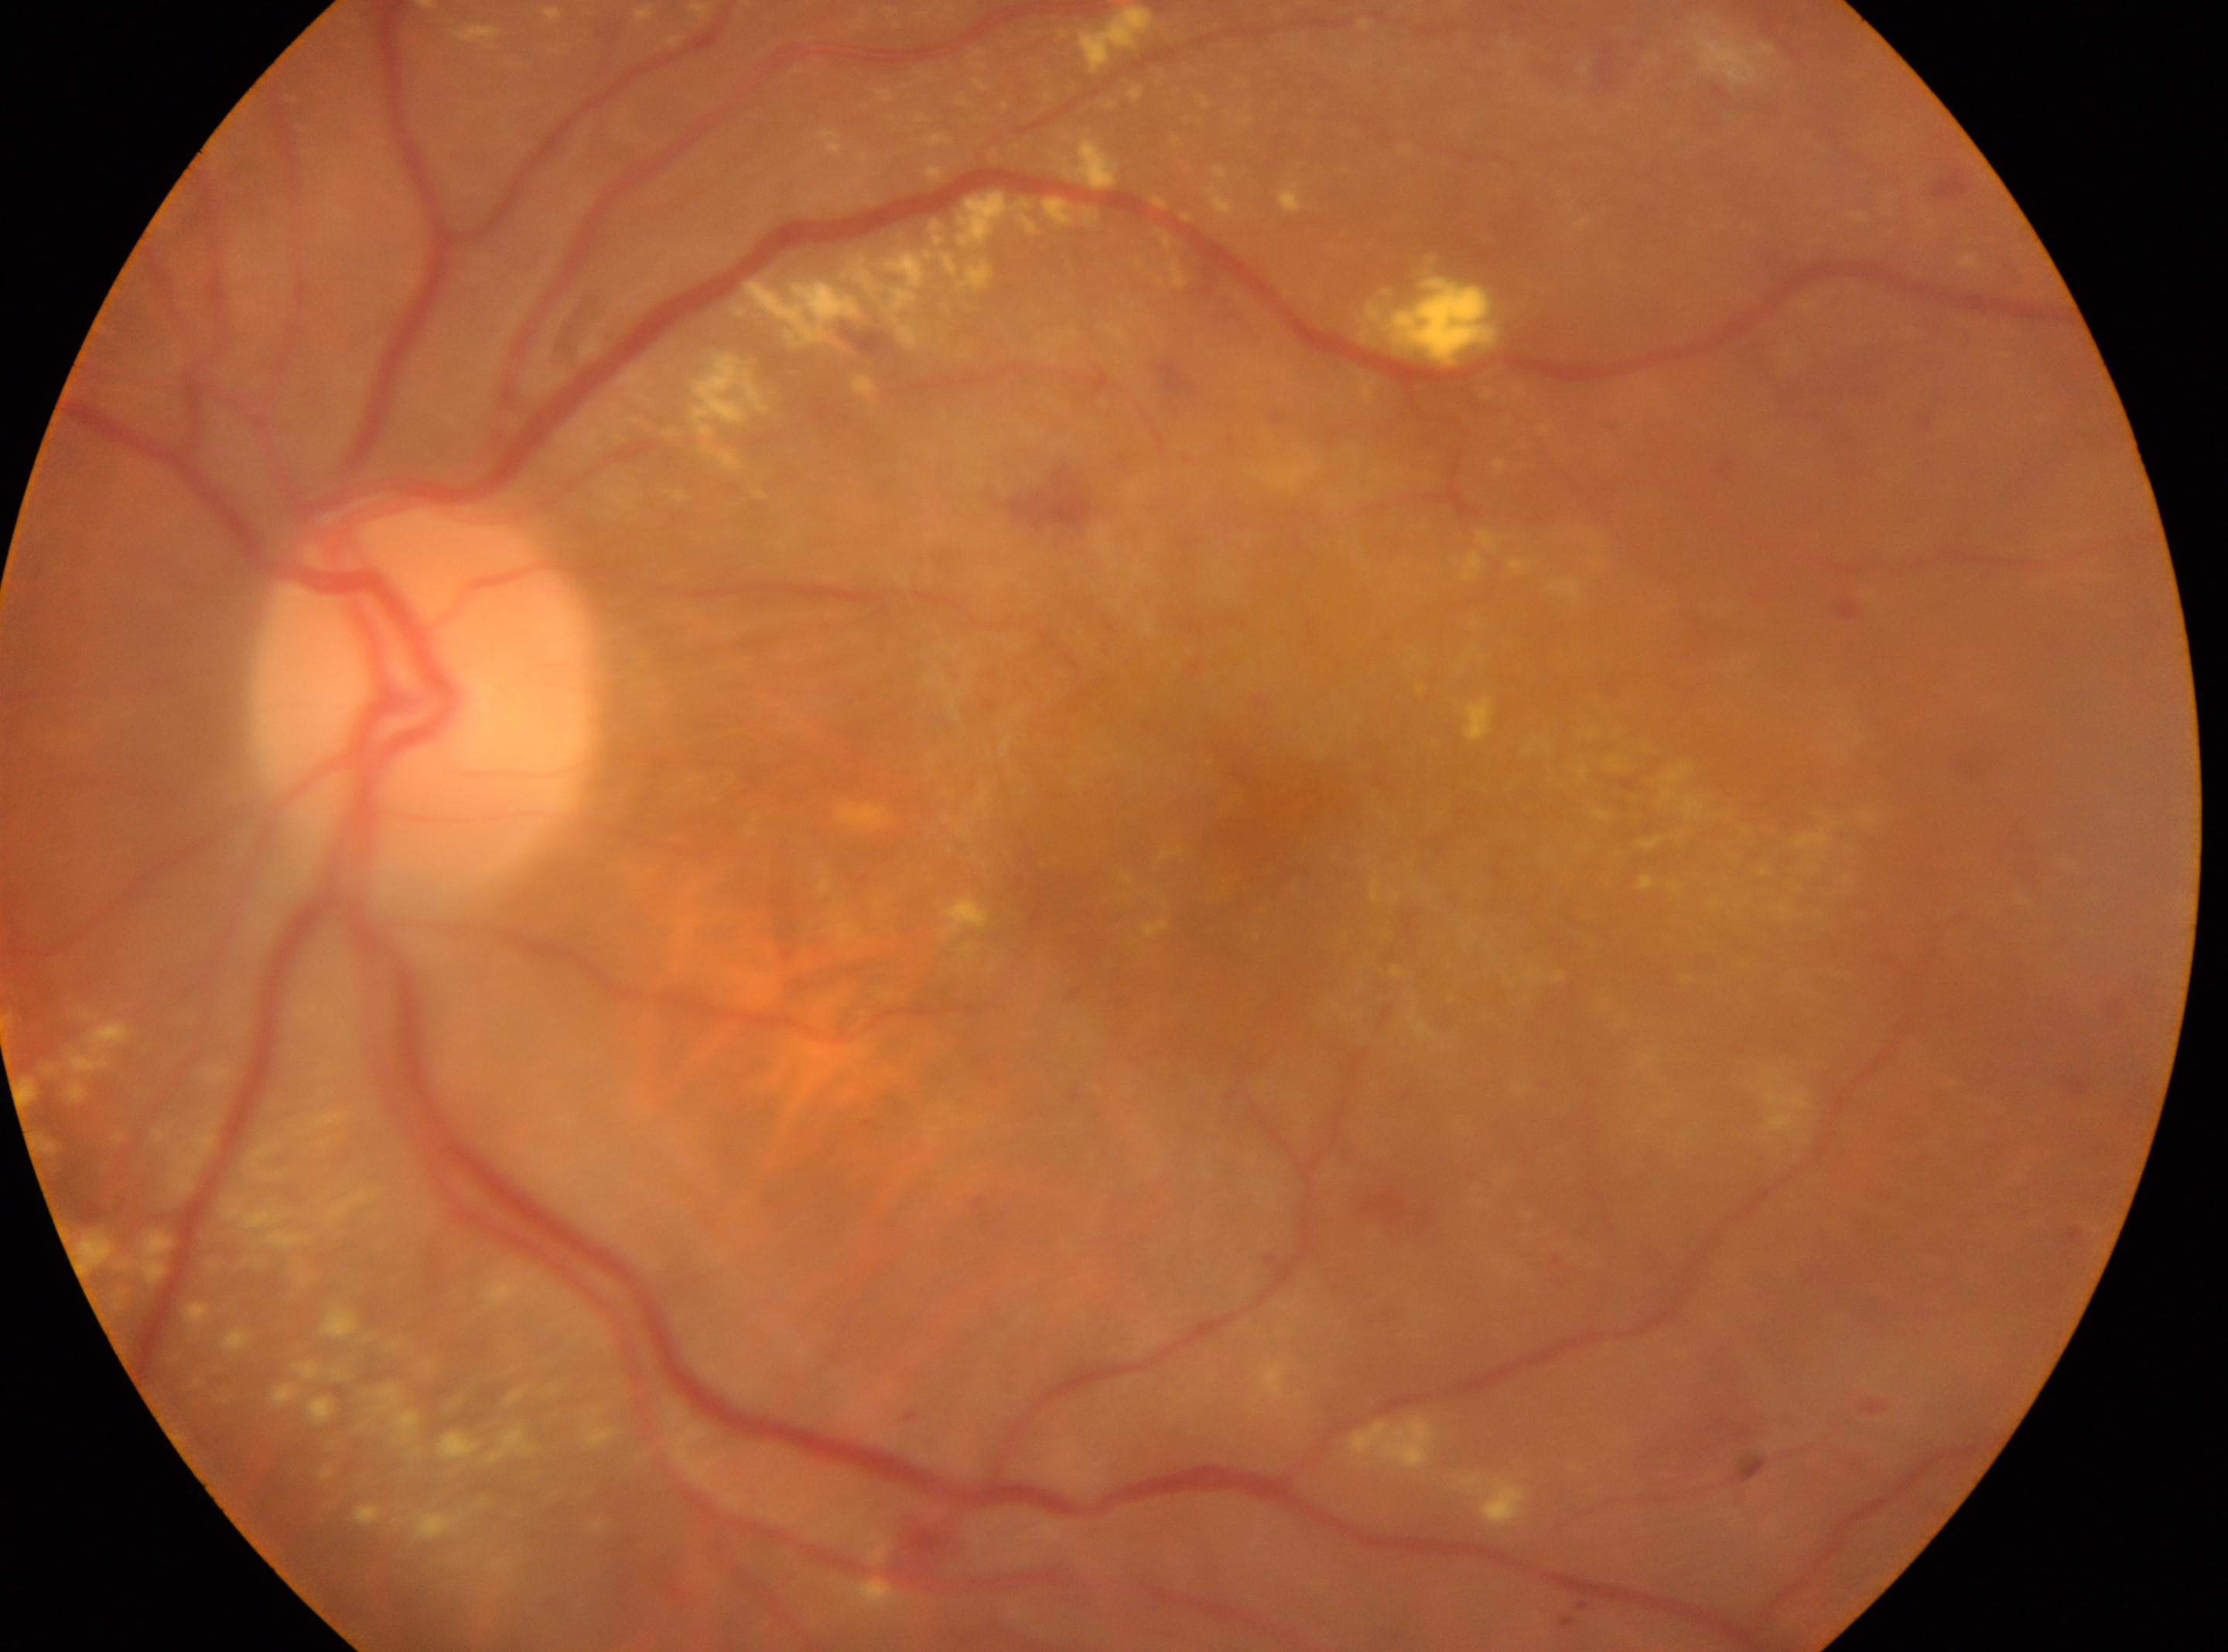 Macular center: [1252, 834]. The image shows the OS. Retinopathy is grade 2. Disc center: [421, 687].